DR severity per modified Davis staging — 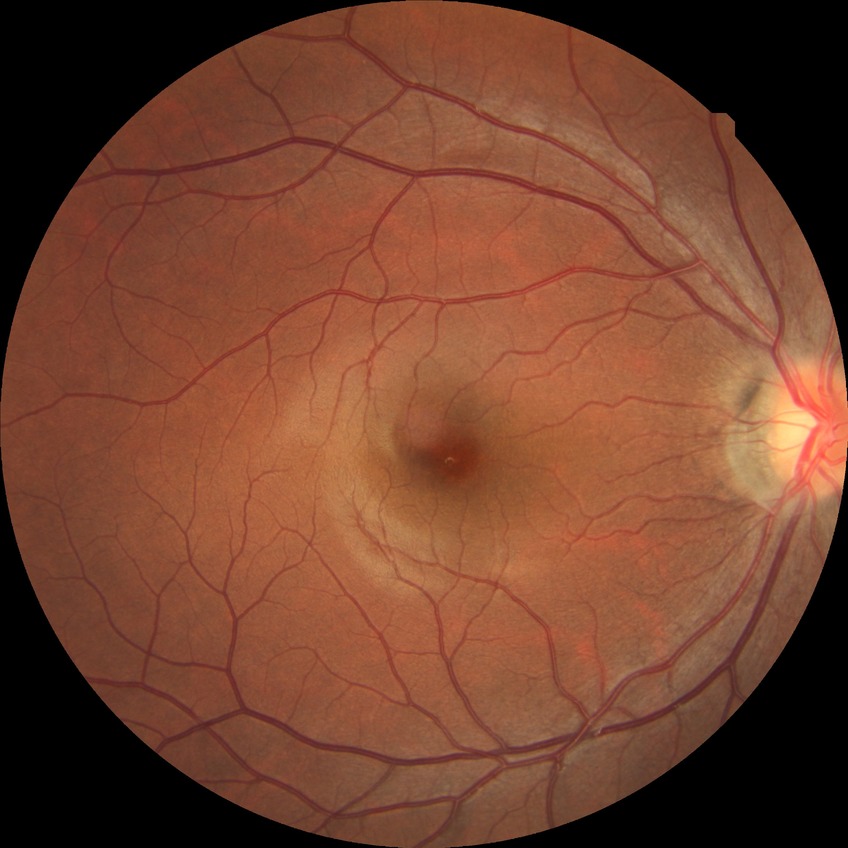
Diabetic retinopathy (DR) is NDR (no diabetic retinopathy).